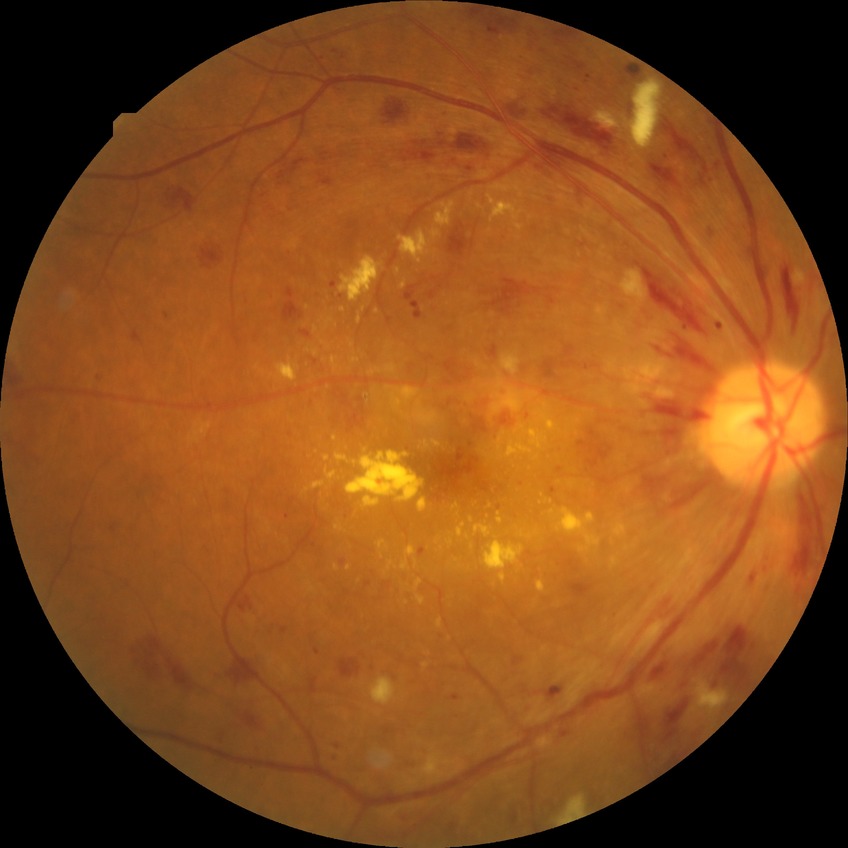
Diabetic retinopathy (DR) is PDR (proliferative diabetic retinopathy).